Fundus photo taken with a portable handheld camera. FOV: 60 degrees.
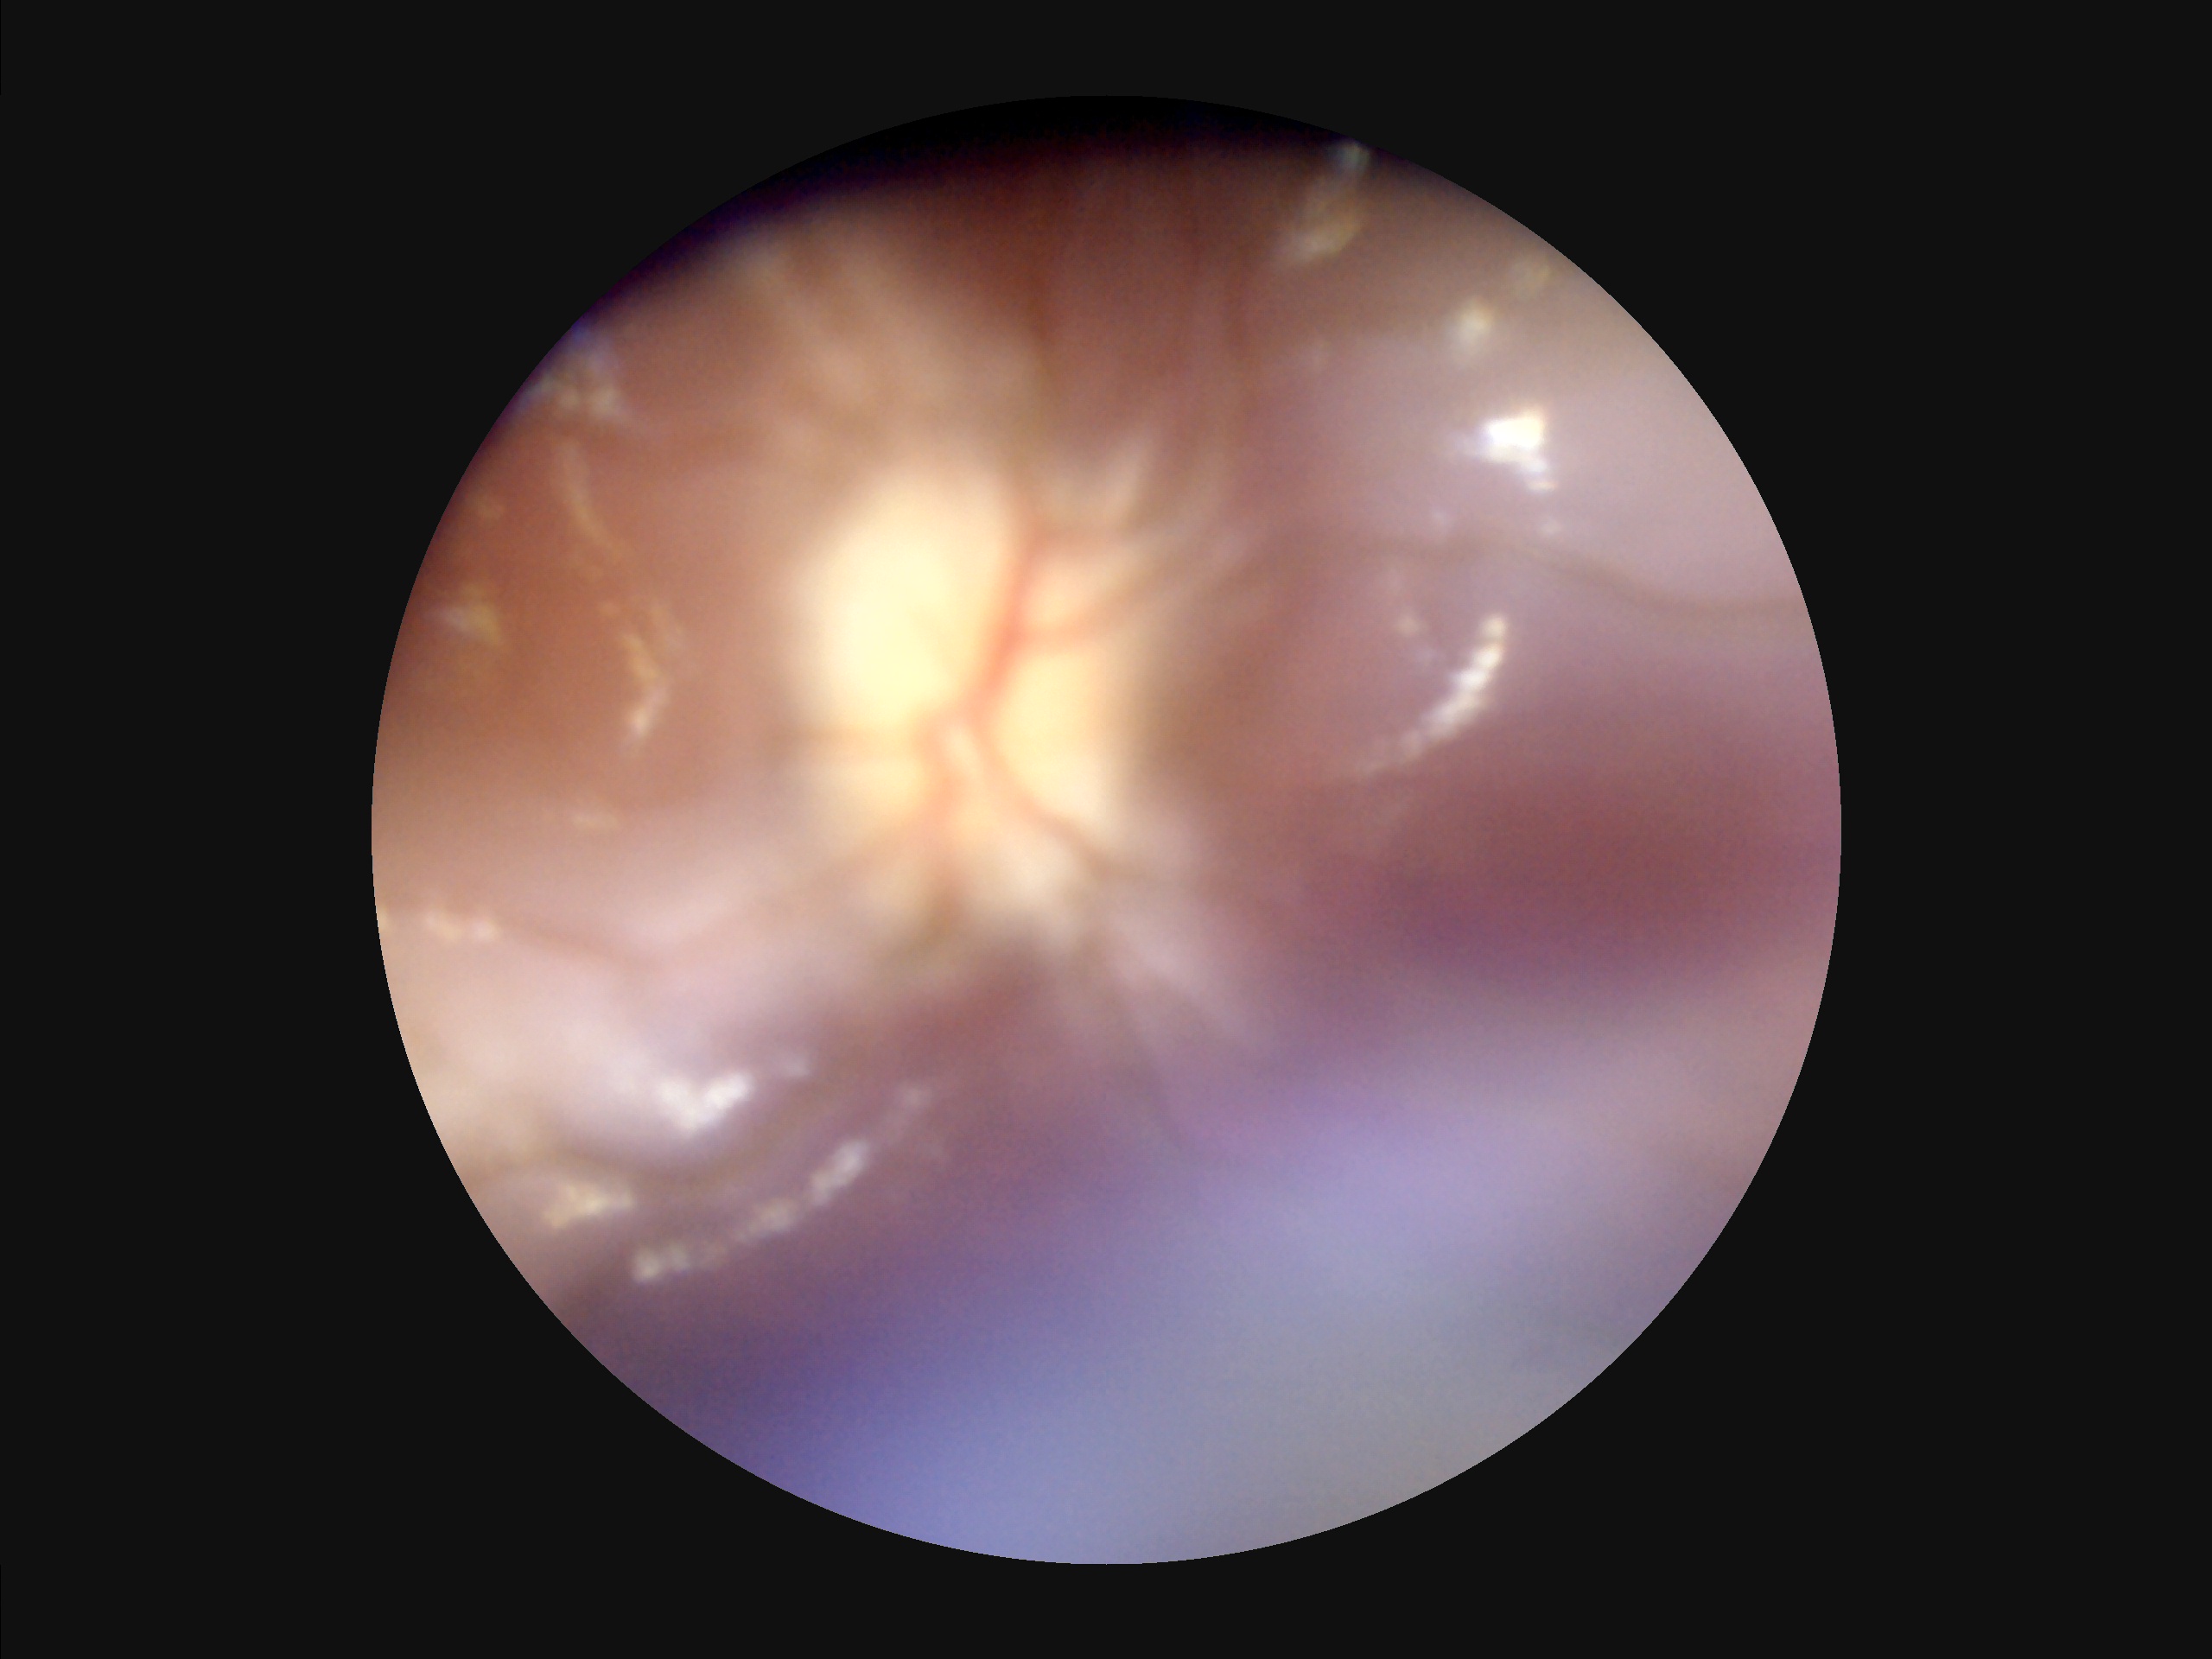

Focus: reduced sharpness with visible blur | Contrast: narrow intensity range, structures hard to distinguish | Illumination: inadequate, with uneven exposure or color distortion | Overall: poor, ungradable.